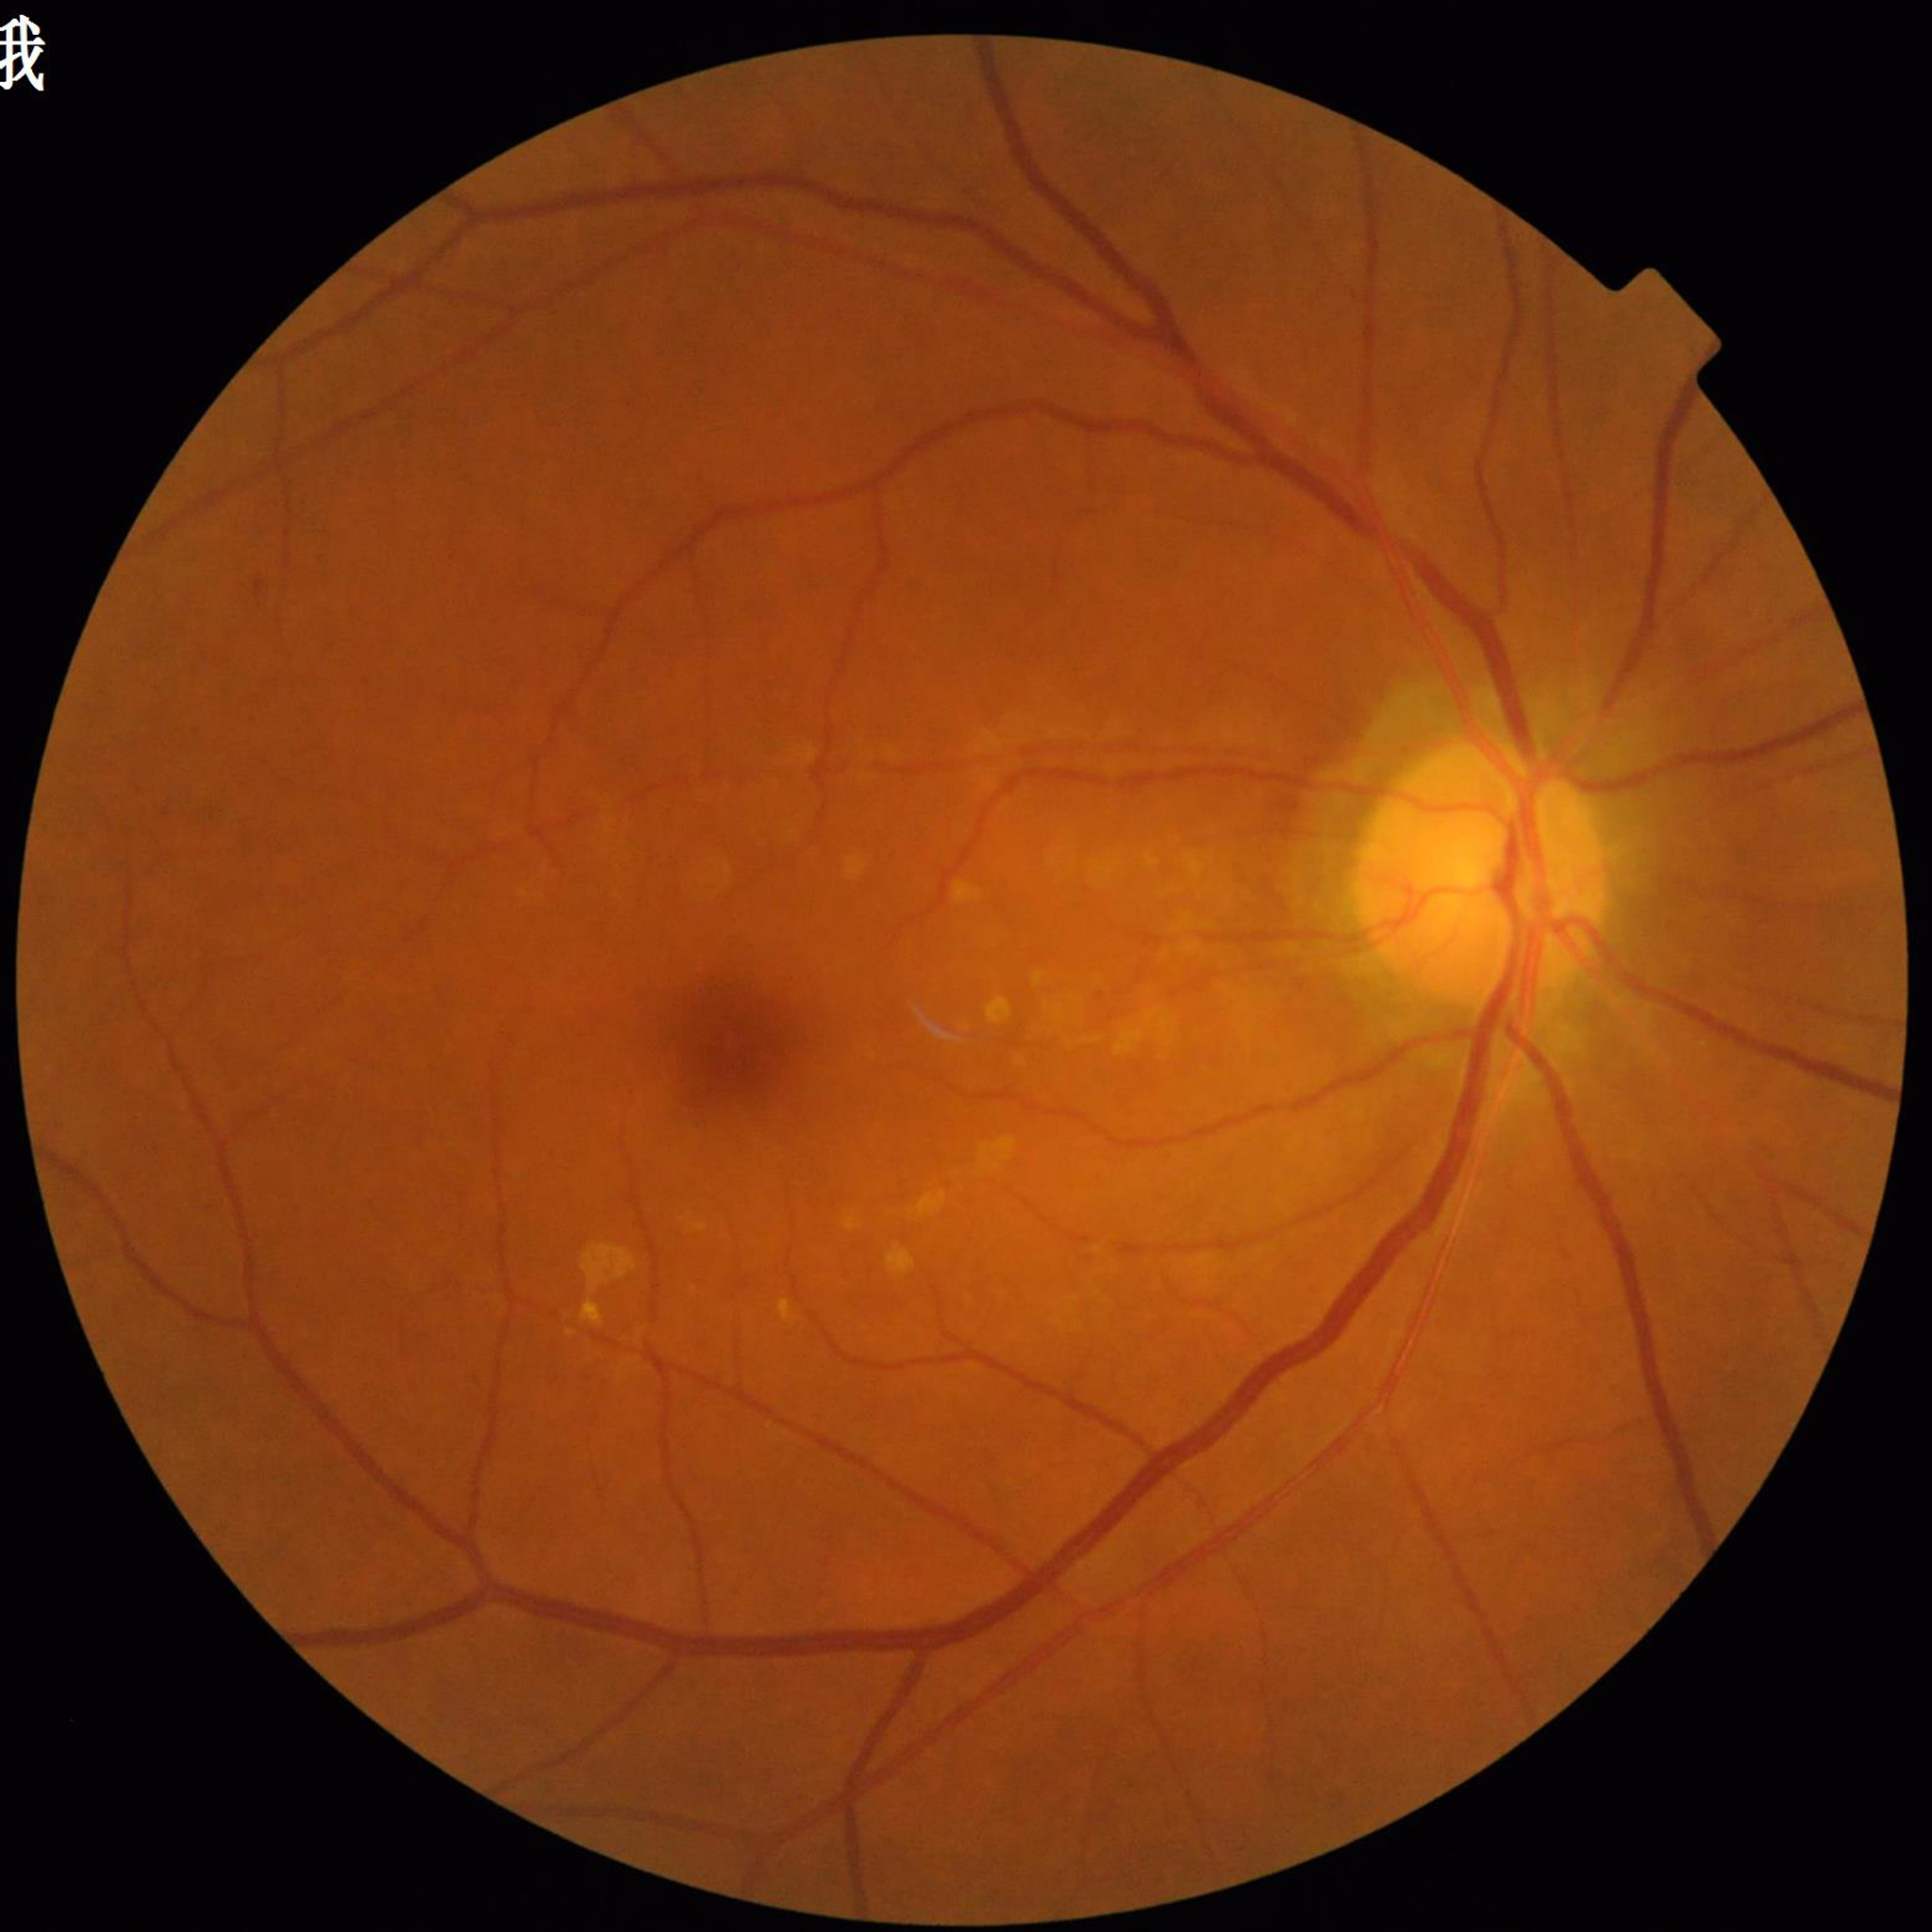
Disease class: diabetic retinopathy.